Posterior pole view: 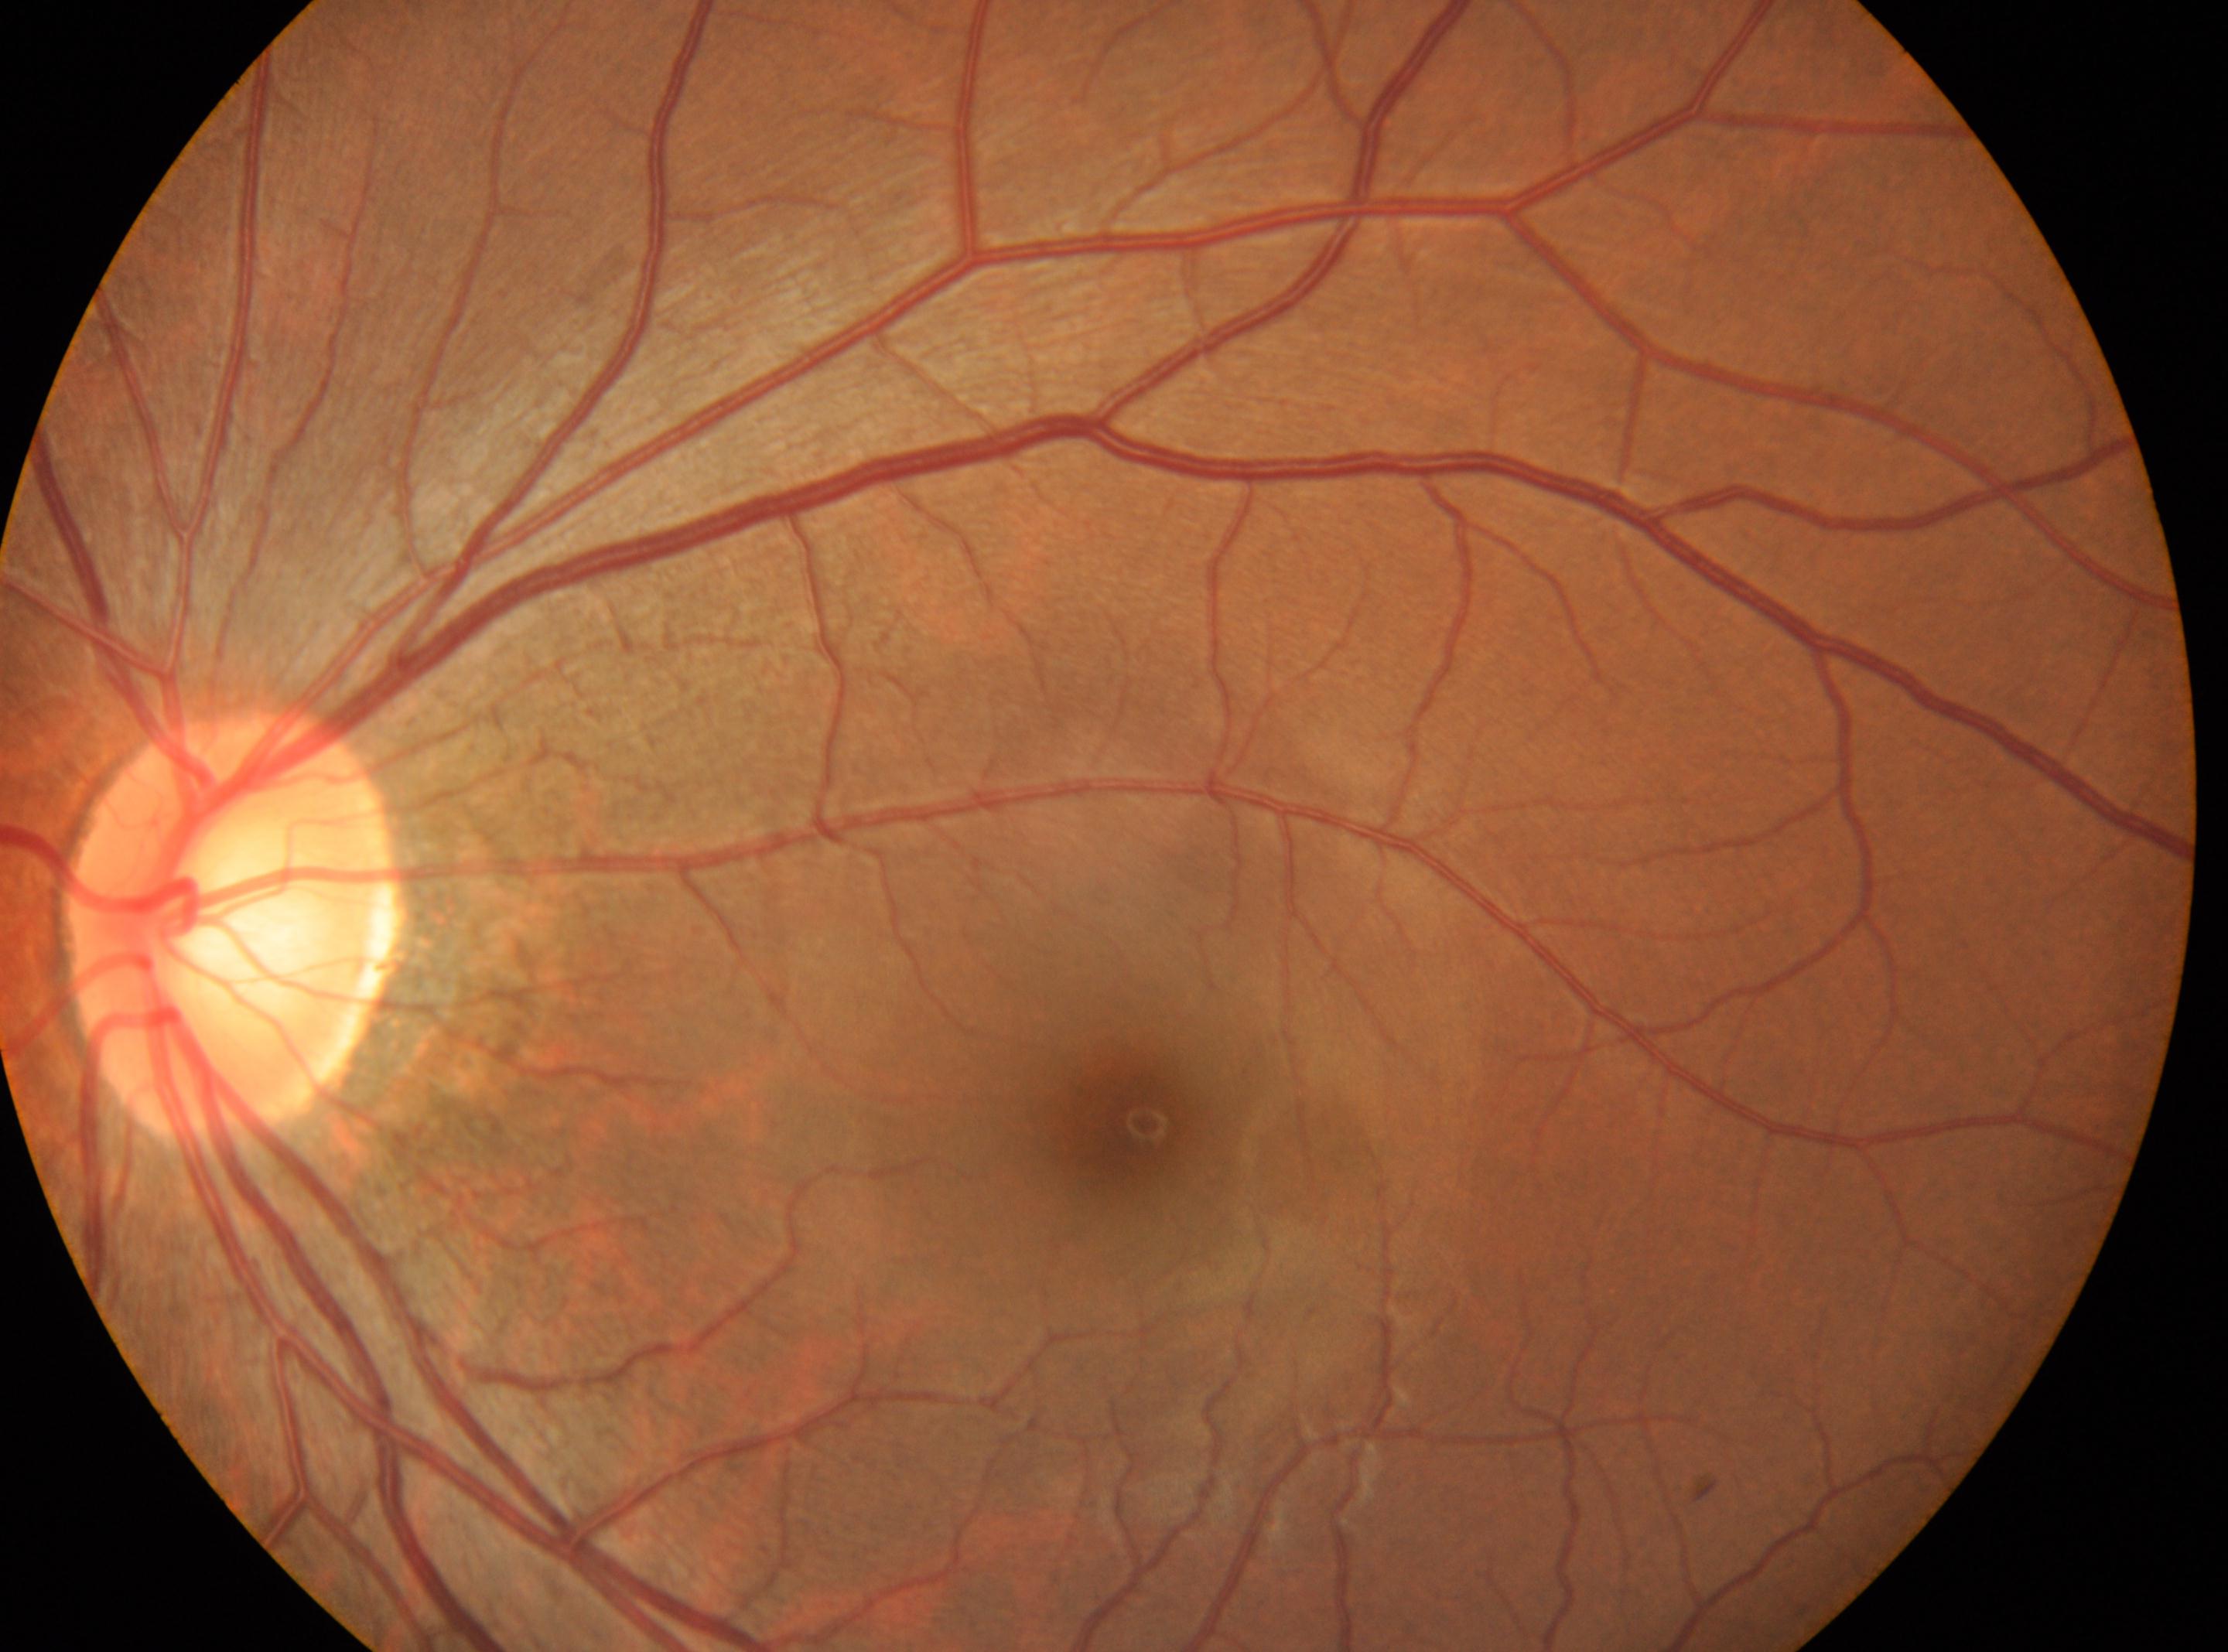

The optic disk is at (x=234, y=927).
Fovea centralis: (x=1133, y=1125).
The image shows the oculus sinister.
DR severity is no apparent diabetic retinopathy (grade 0).
No DR findings.